Ultra-widefield fundus mosaic. 200-degree field of view:
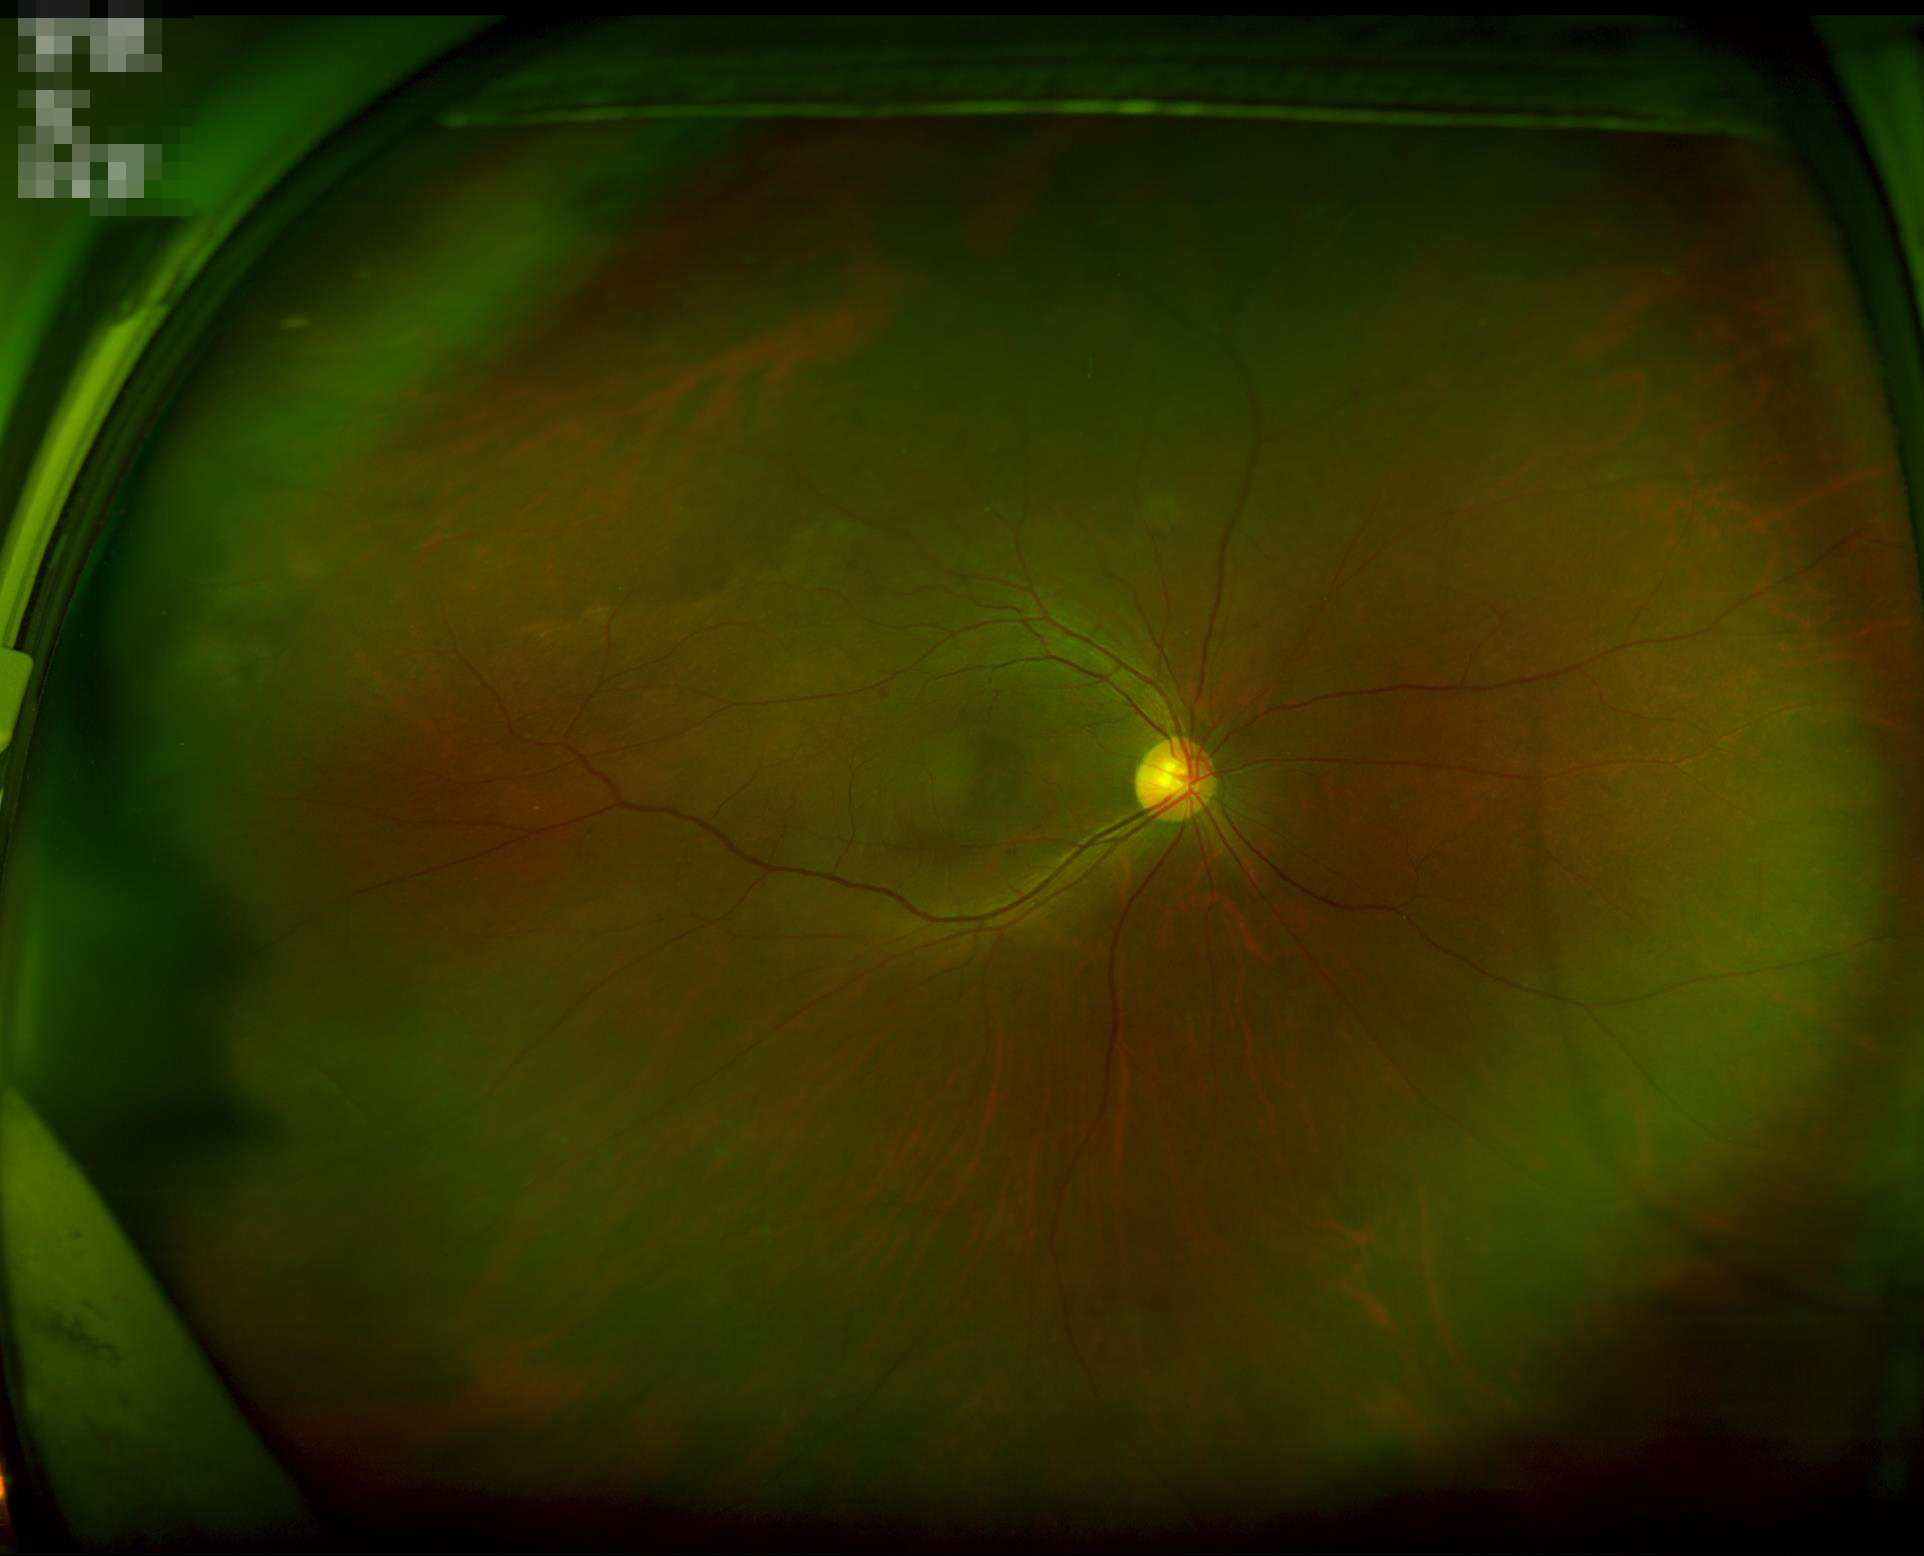
The image is clear. No over- or under-exposure. Acceptable image quality.